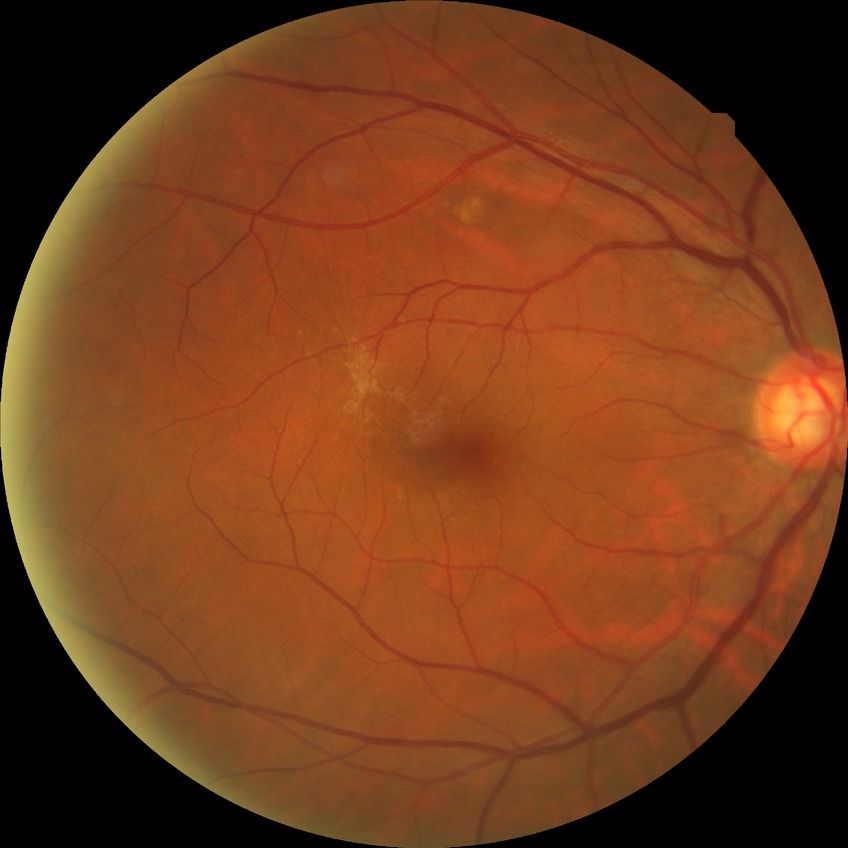 Diabetic retinopathy (DR) is no diabetic retinopathy (NDR).